Portable fundus photograph:
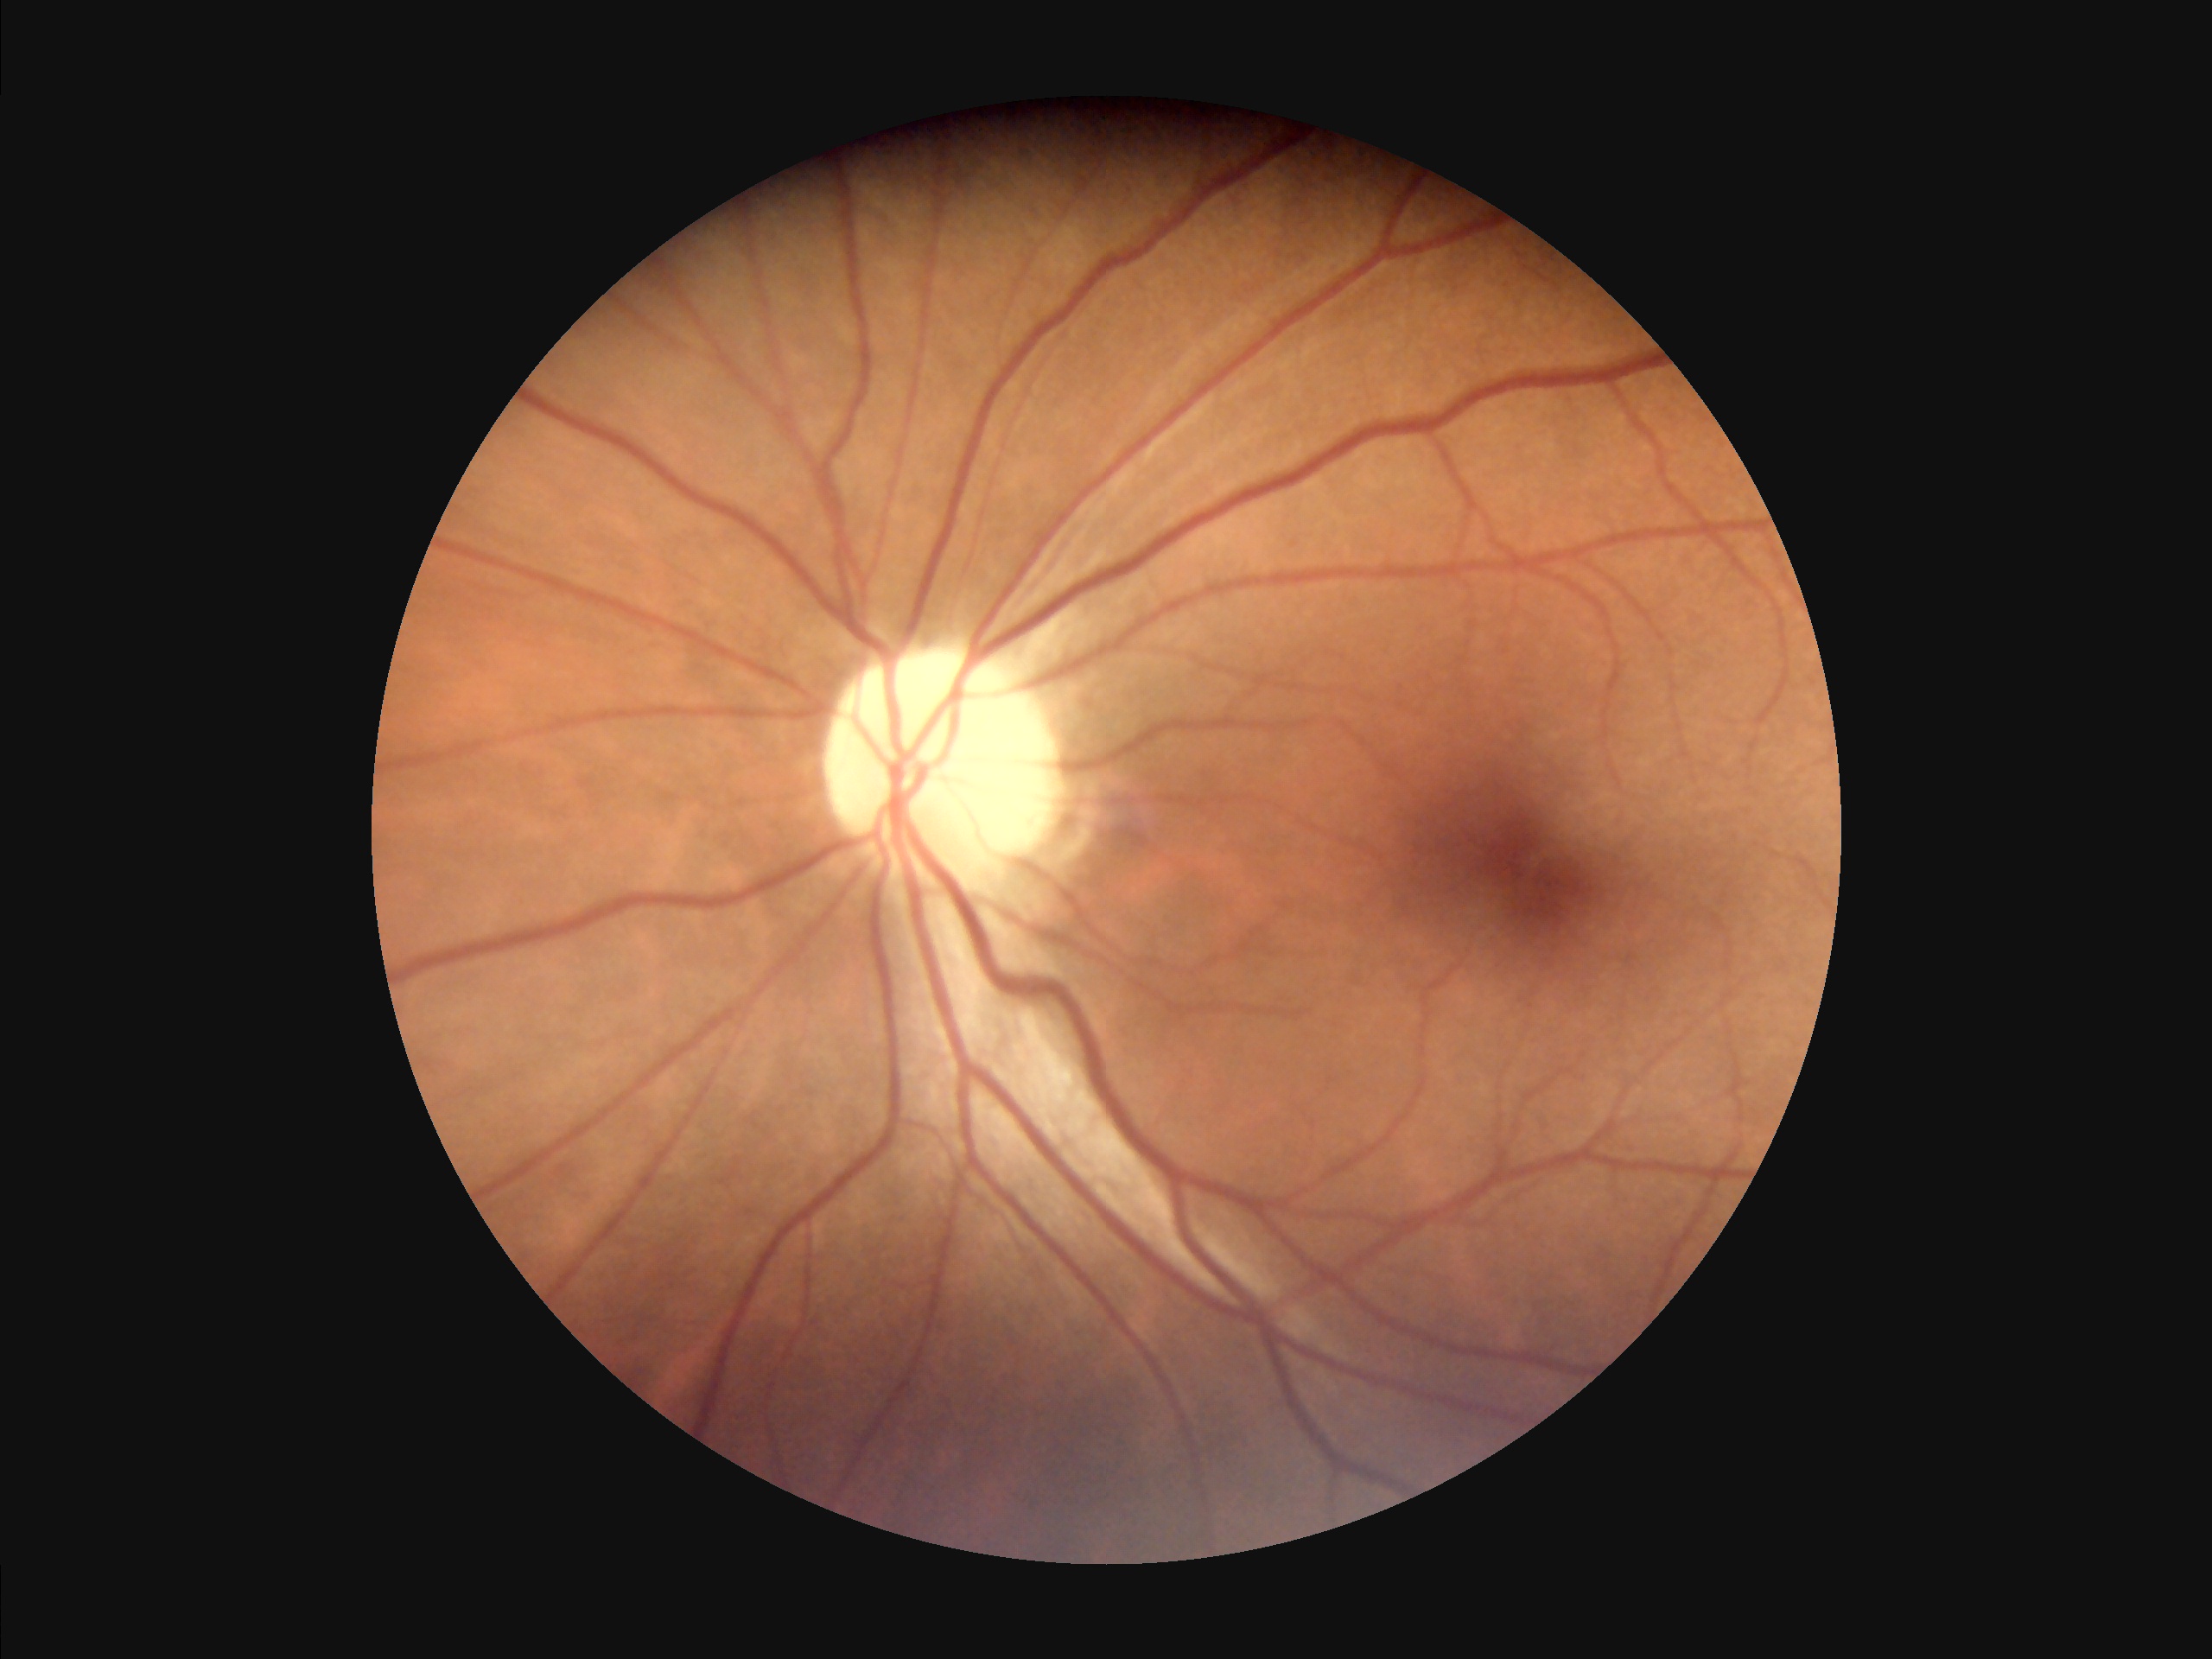 Image quality assessment:
- illumination: good
- contrast: satisfactory
- clarity: in focus